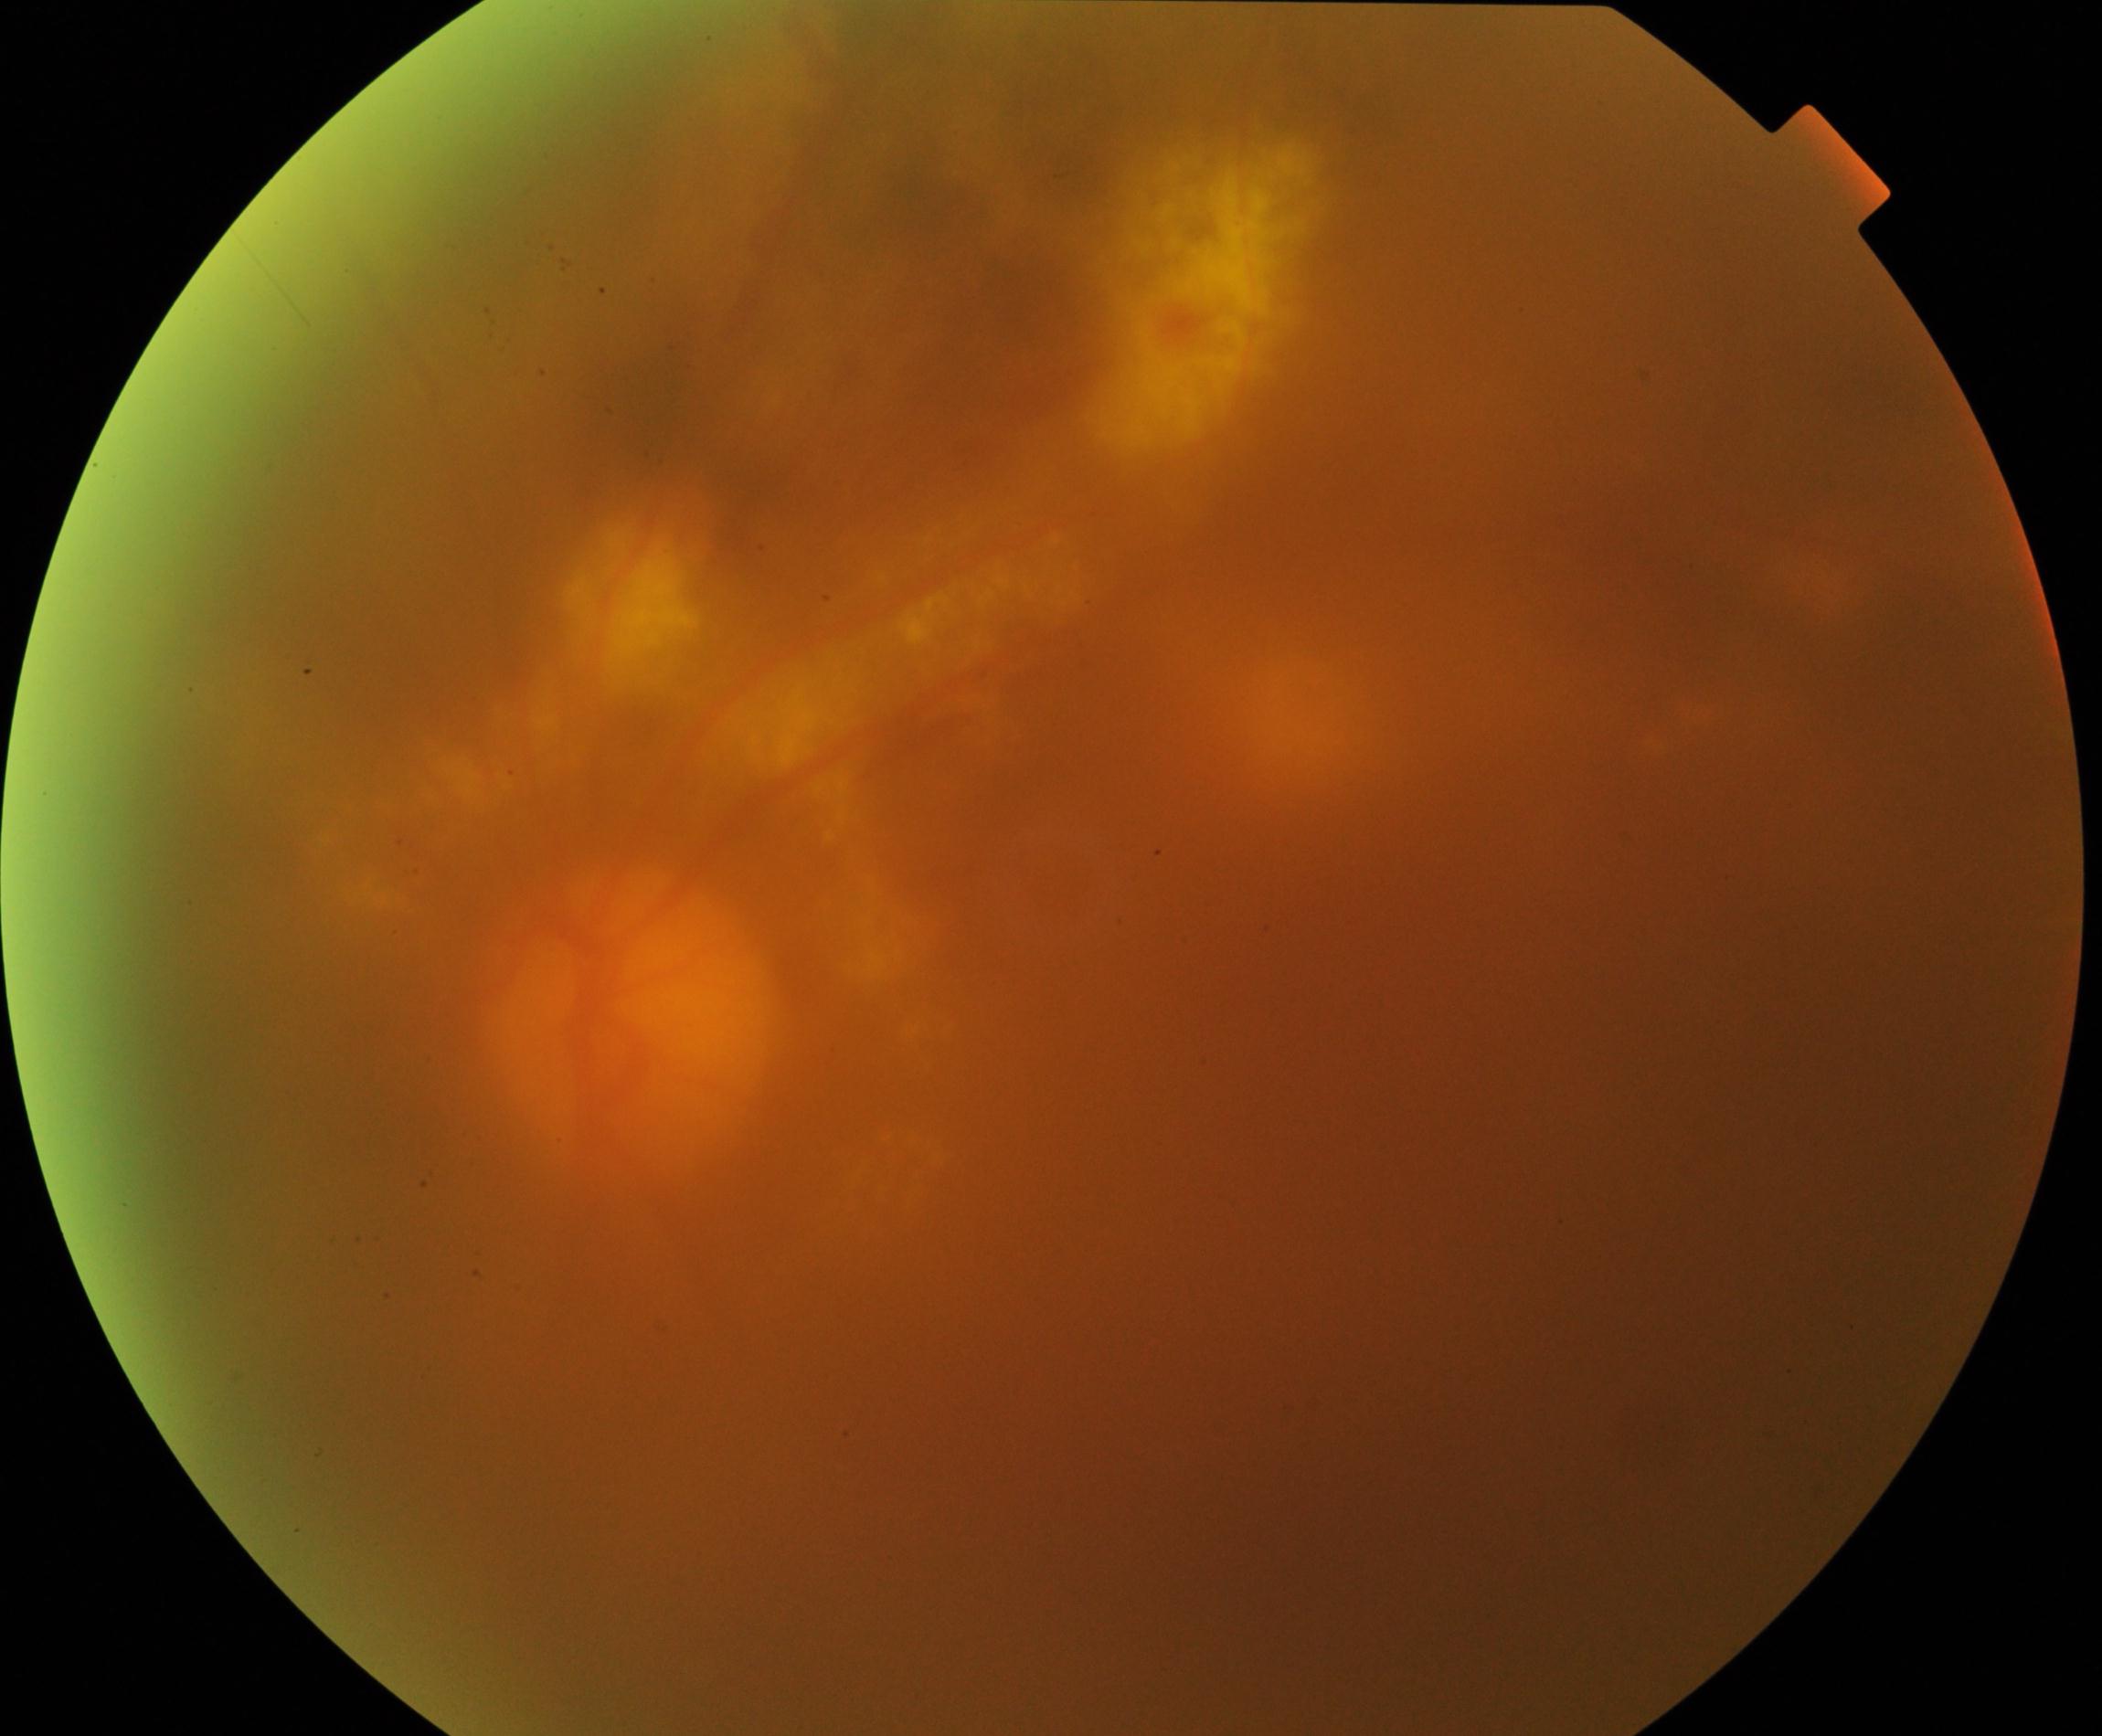 Image is blurred; retinal landmarks are largely obscured. Suspected proliferative diabetic retinopathy.